Pediatric retinal photograph (wide-field). Natus RetCam Envision, 130° FOV. 1440 x 1080 pixels
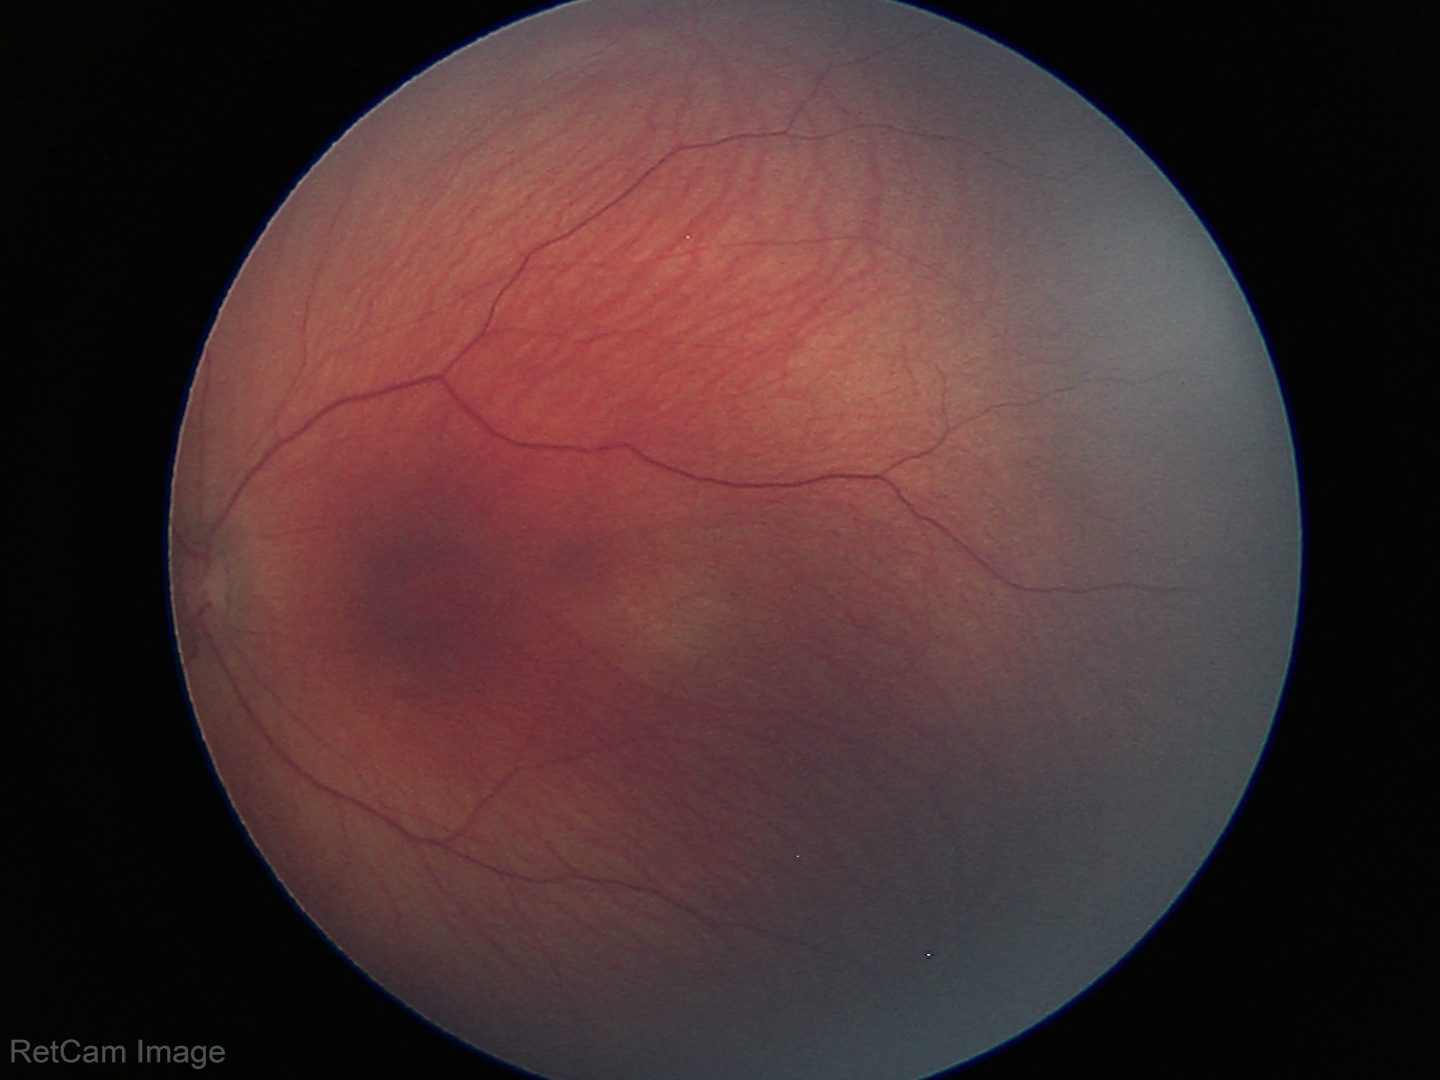
No retinal pathology identified on screening.